Color fundus photograph: 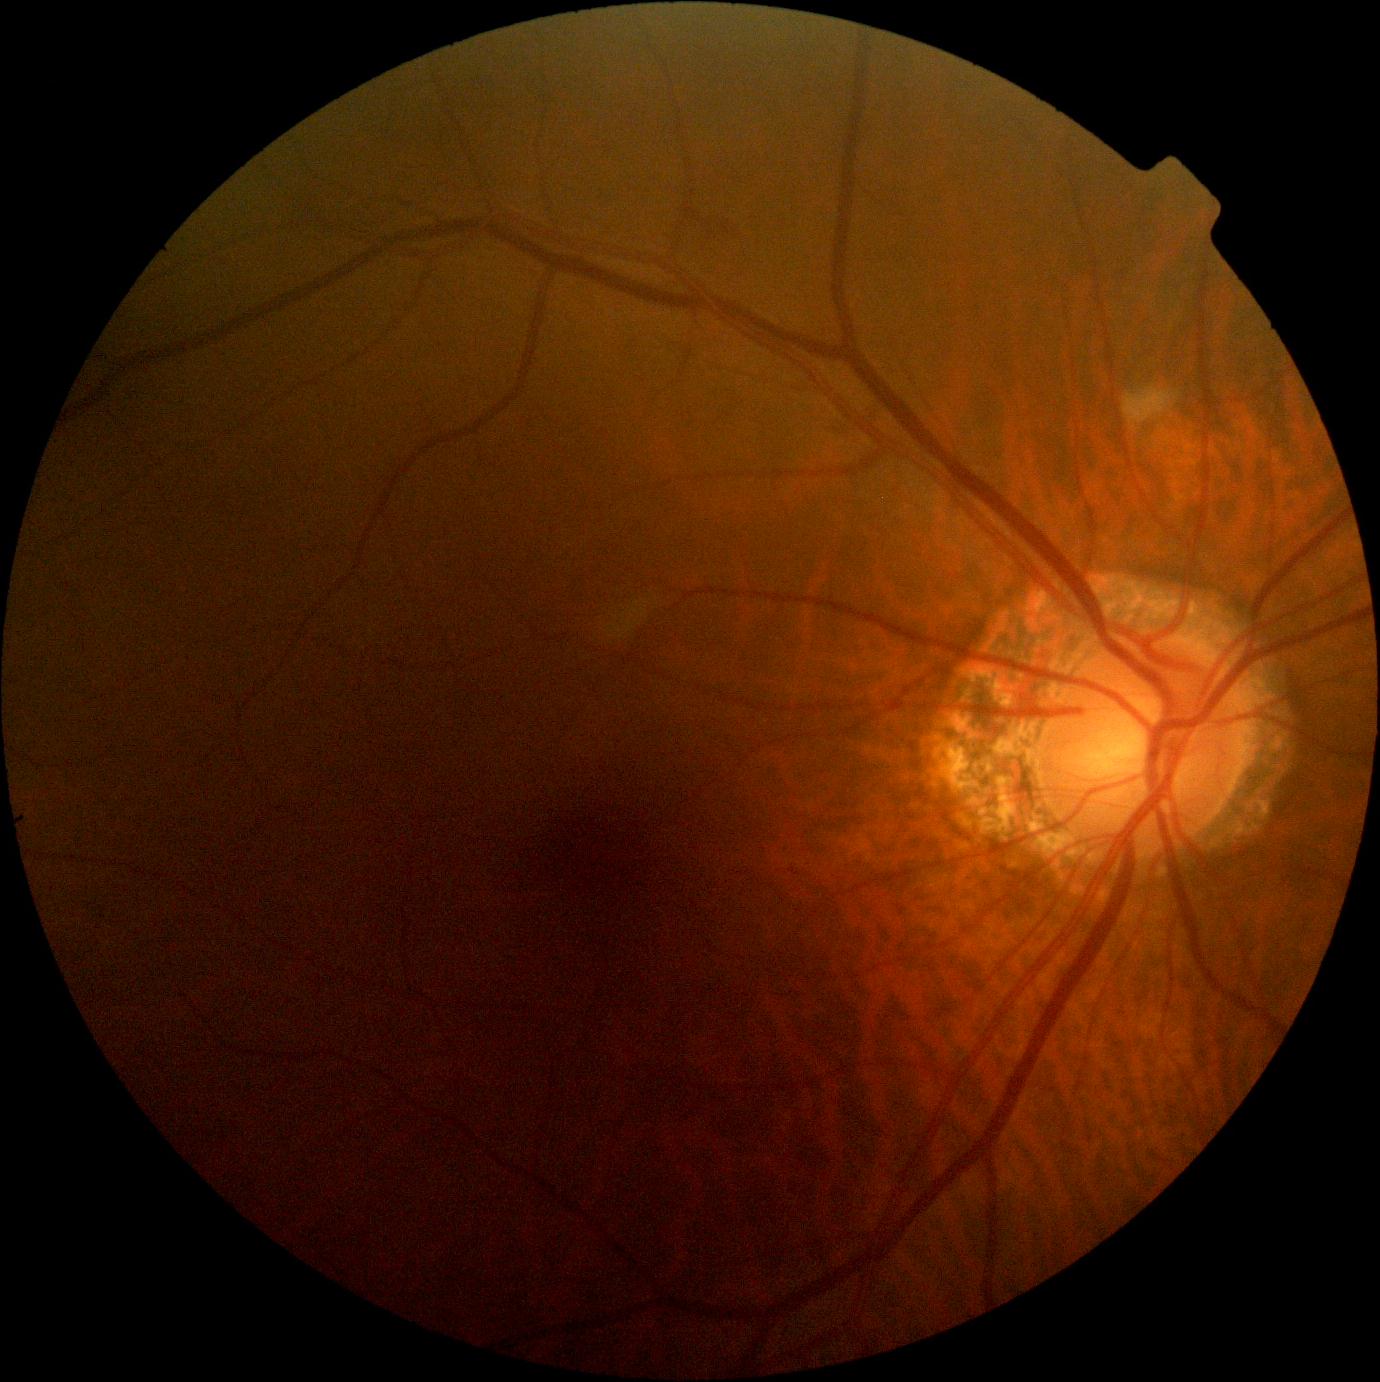

Diabetic retinopathy is grade 2.
DR class: non-proliferative diabetic retinopathy.